Pediatric retinal photograph (wide-field); 130° field of view (Clarity RetCam 3); 640 by 480 pixels — 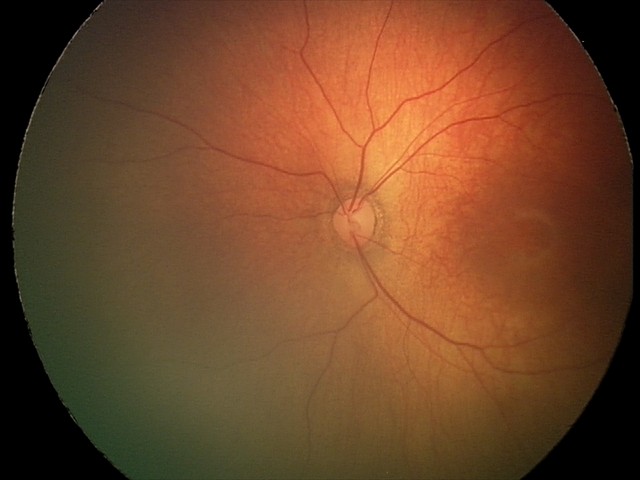 Screening diagnosis: normal retinal appearance.